CFP · captured on a Forus 3Nethra Classic — 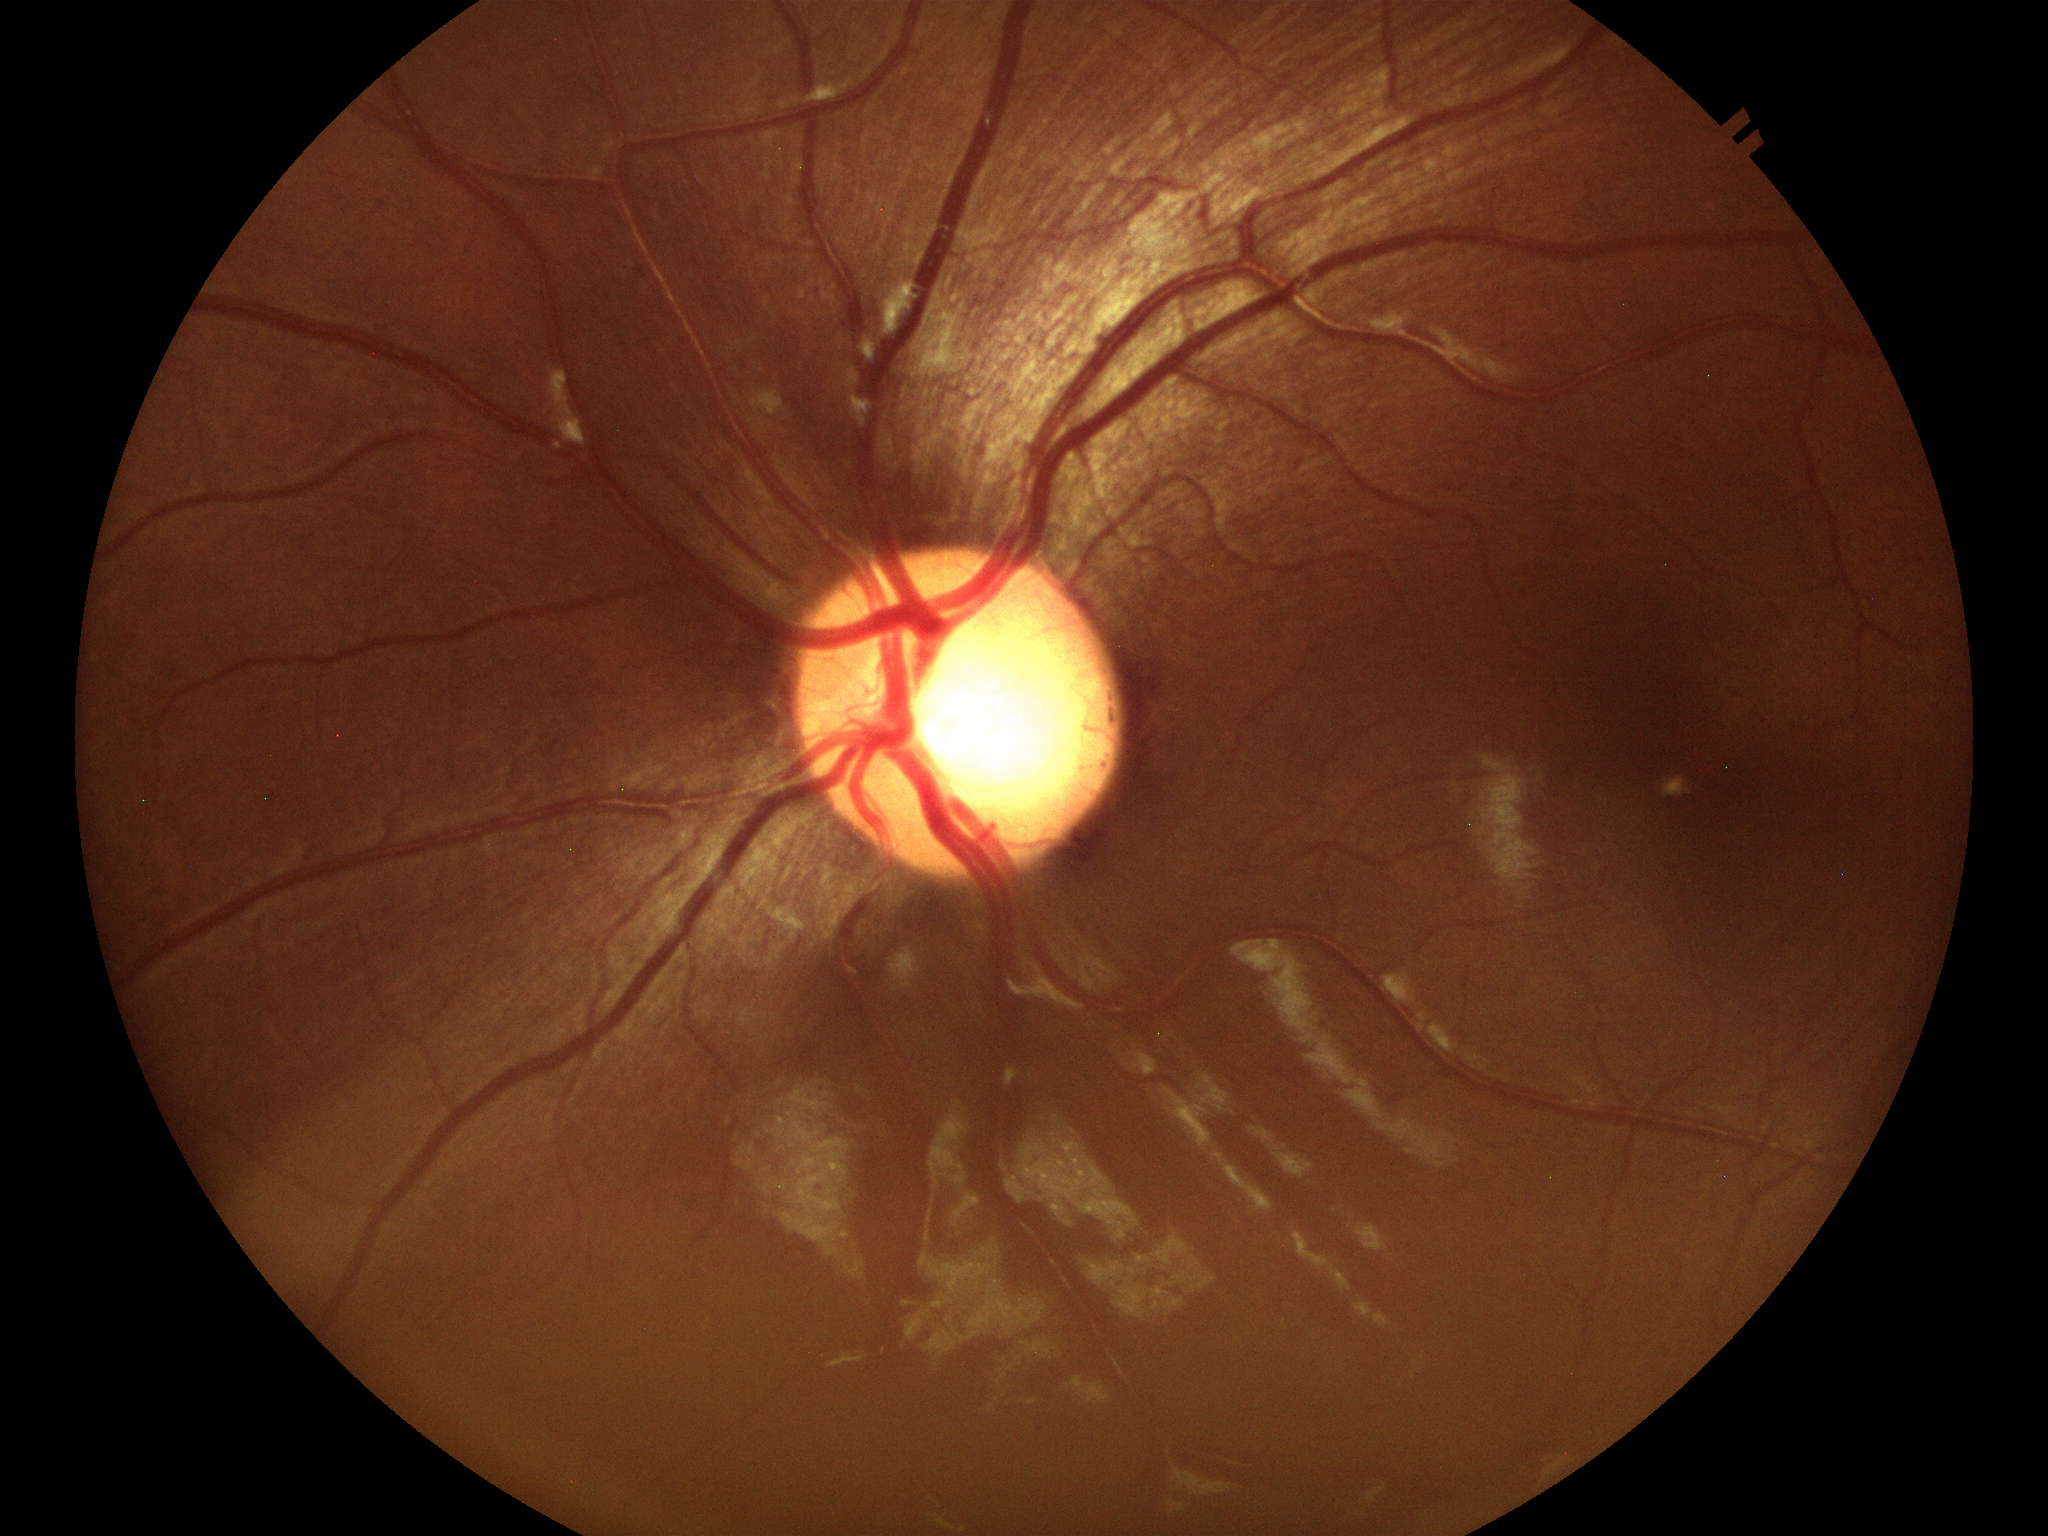
Glaucoma decision: suspect
horizontal C/D ratio (HCDR): 0.64
vertical CDR (VCDR): 0.66